Fundus photo taken with a portable handheld camera — 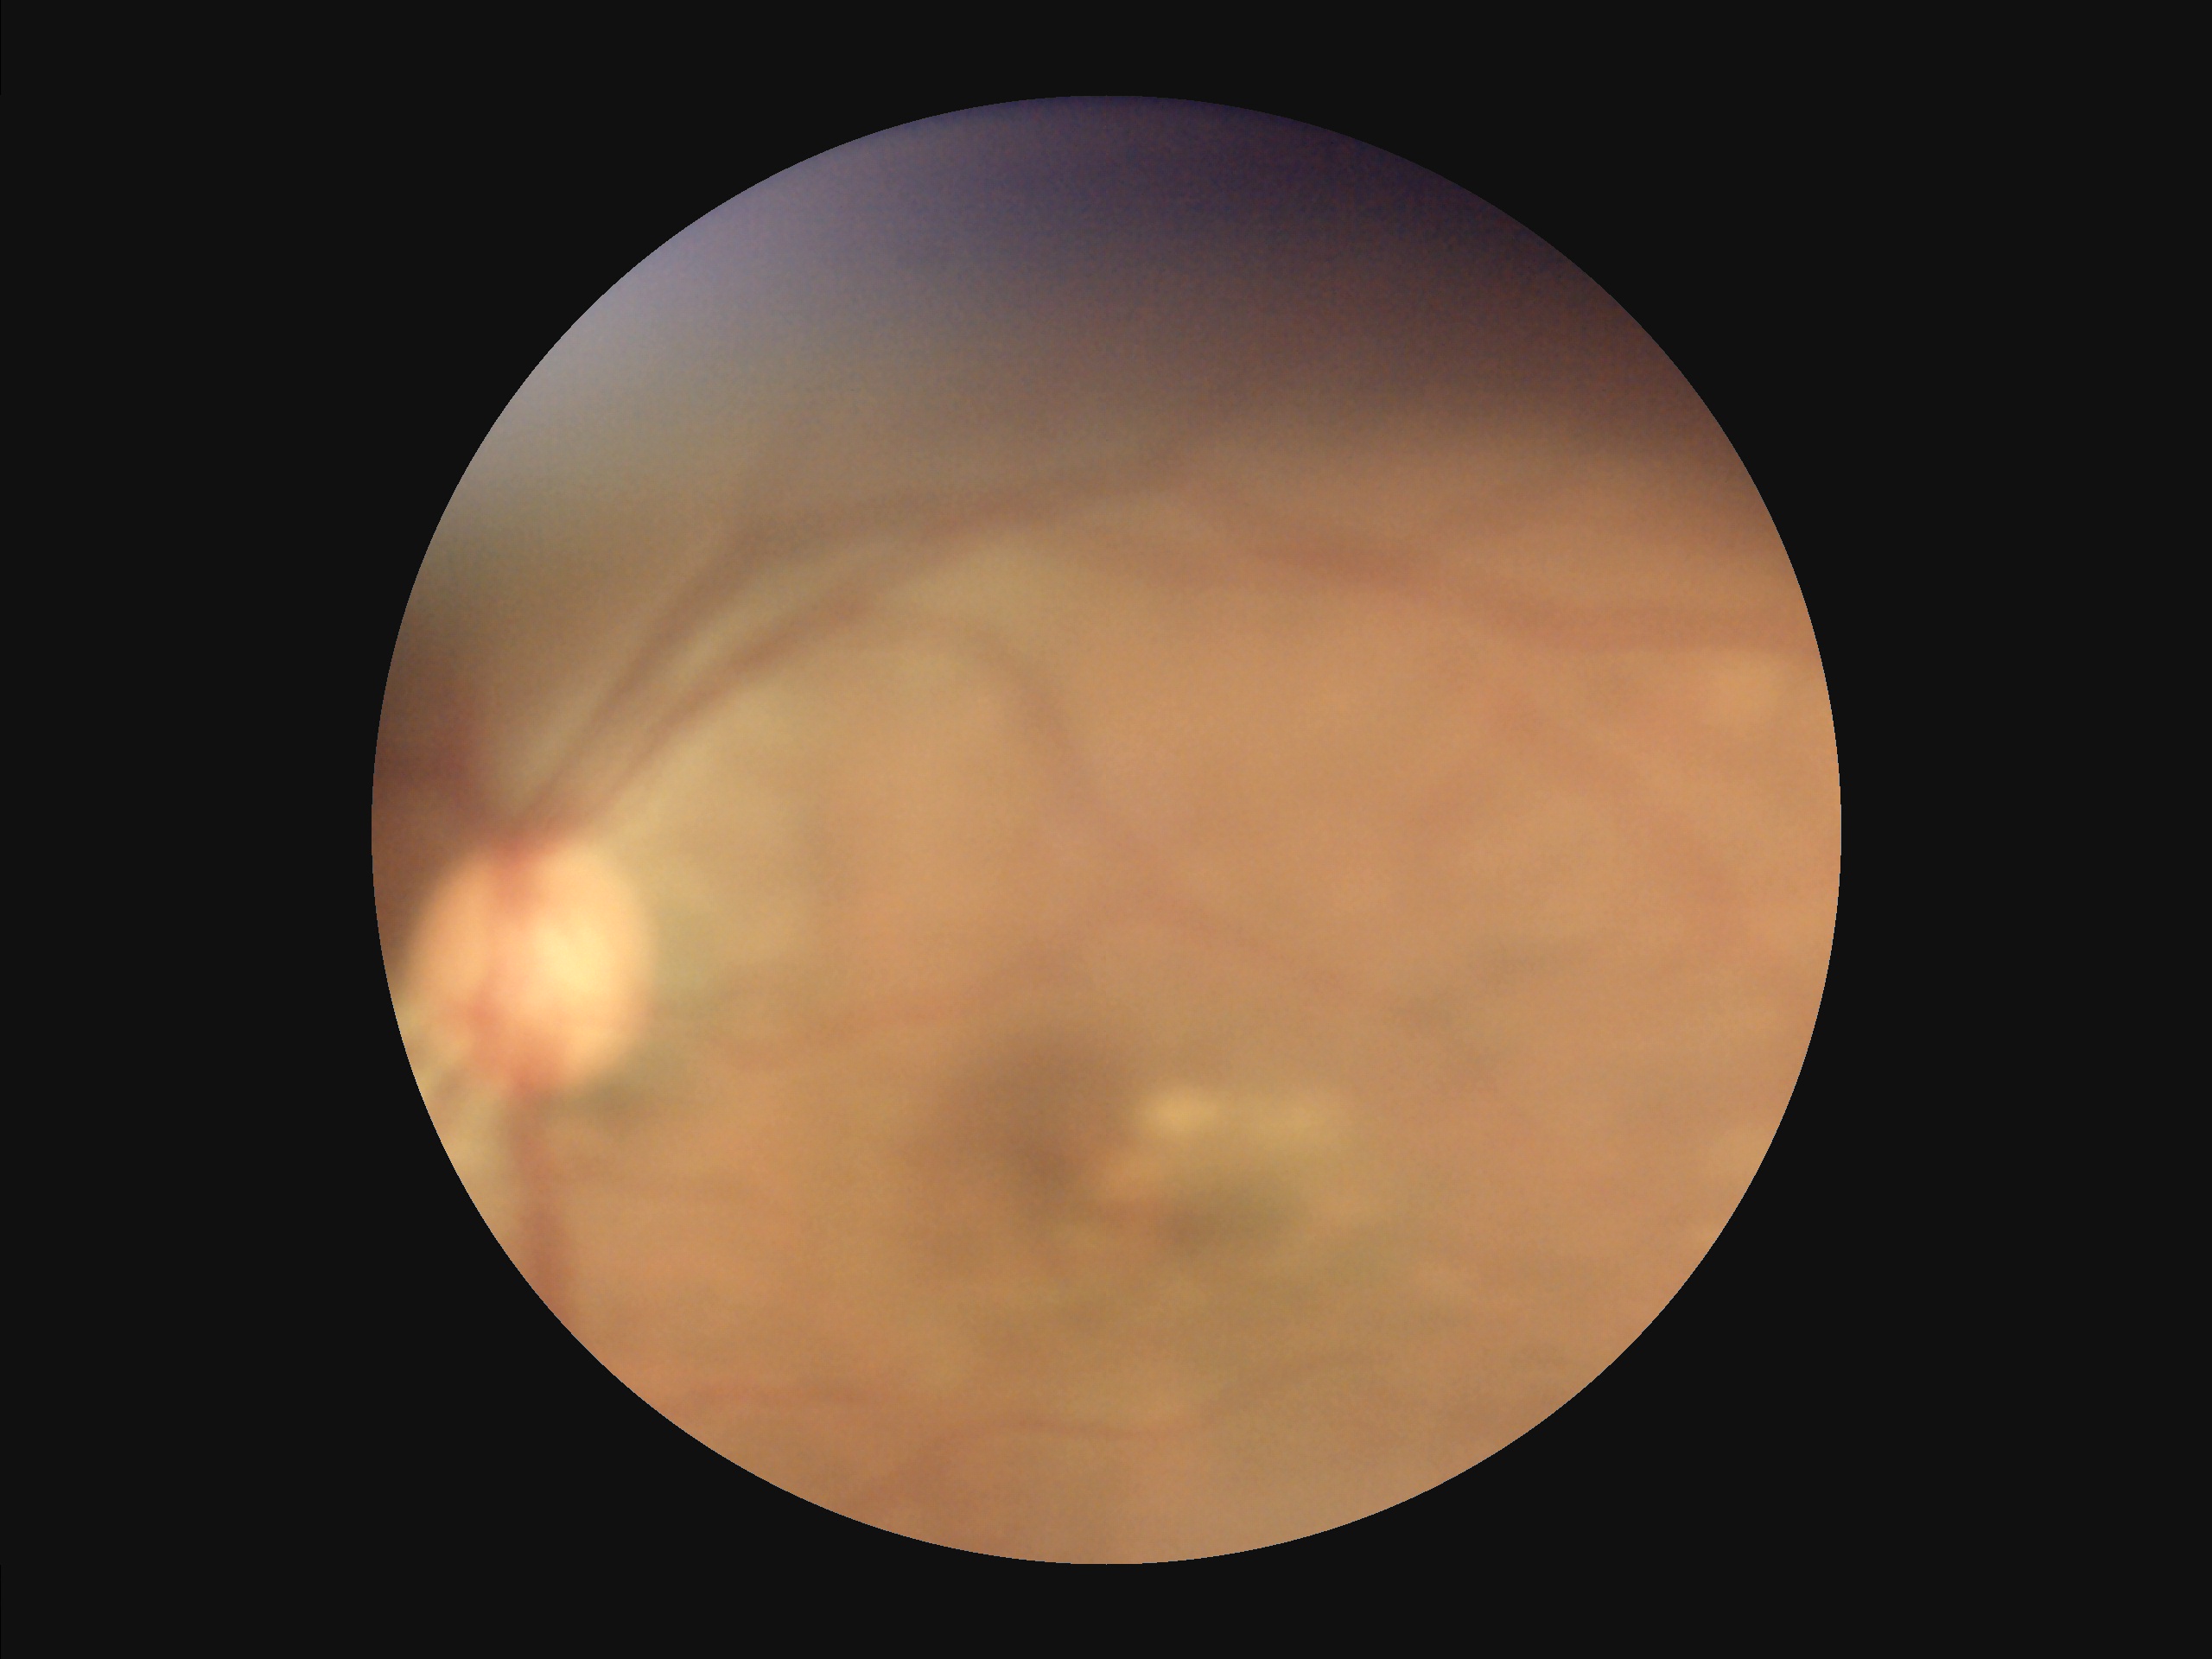

Sharpness: noticeable blur in the optic disc, vessels, or background
Illumination: over- or under-exposed
Contrast: low, vessels and details hard to distinguish
Overall: inadequate for clinical interpretation